Image size 1659x2212: 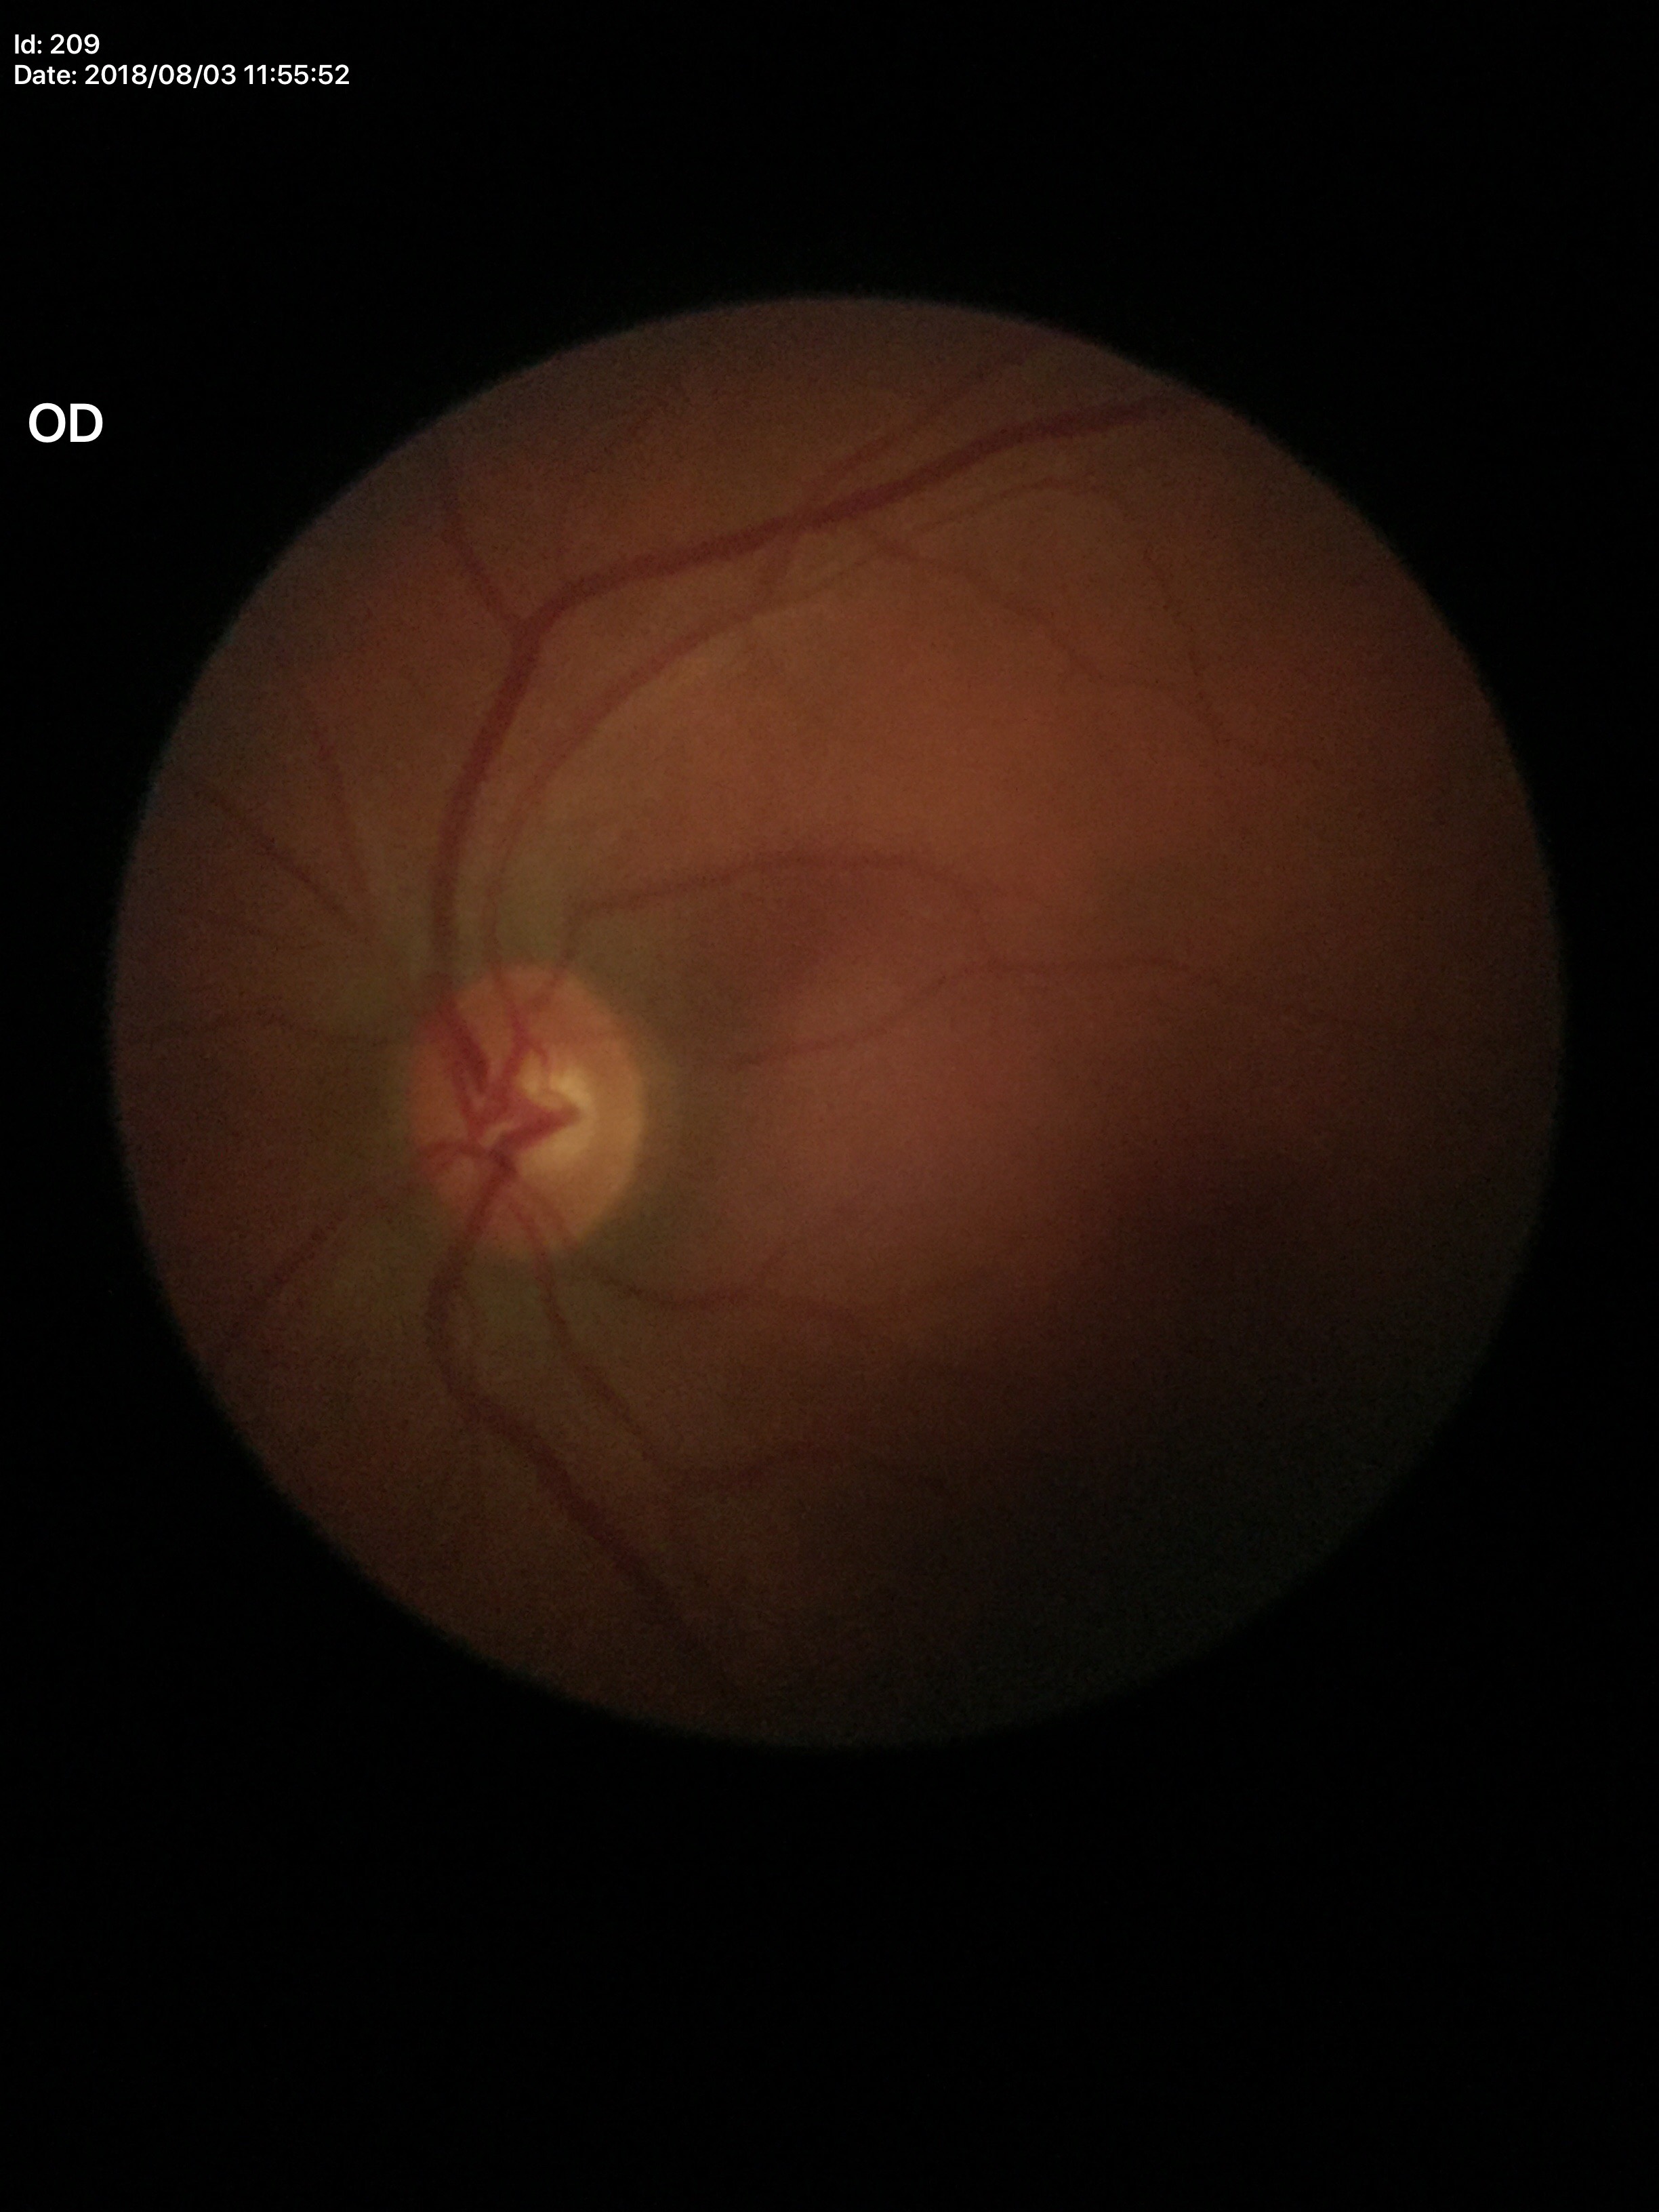

Vertical cup-disc ratio (VCDR) of 0.47.
No glaucomatous optic neuropathy.
Area cup-disc ratio (ACDR): 0.26.